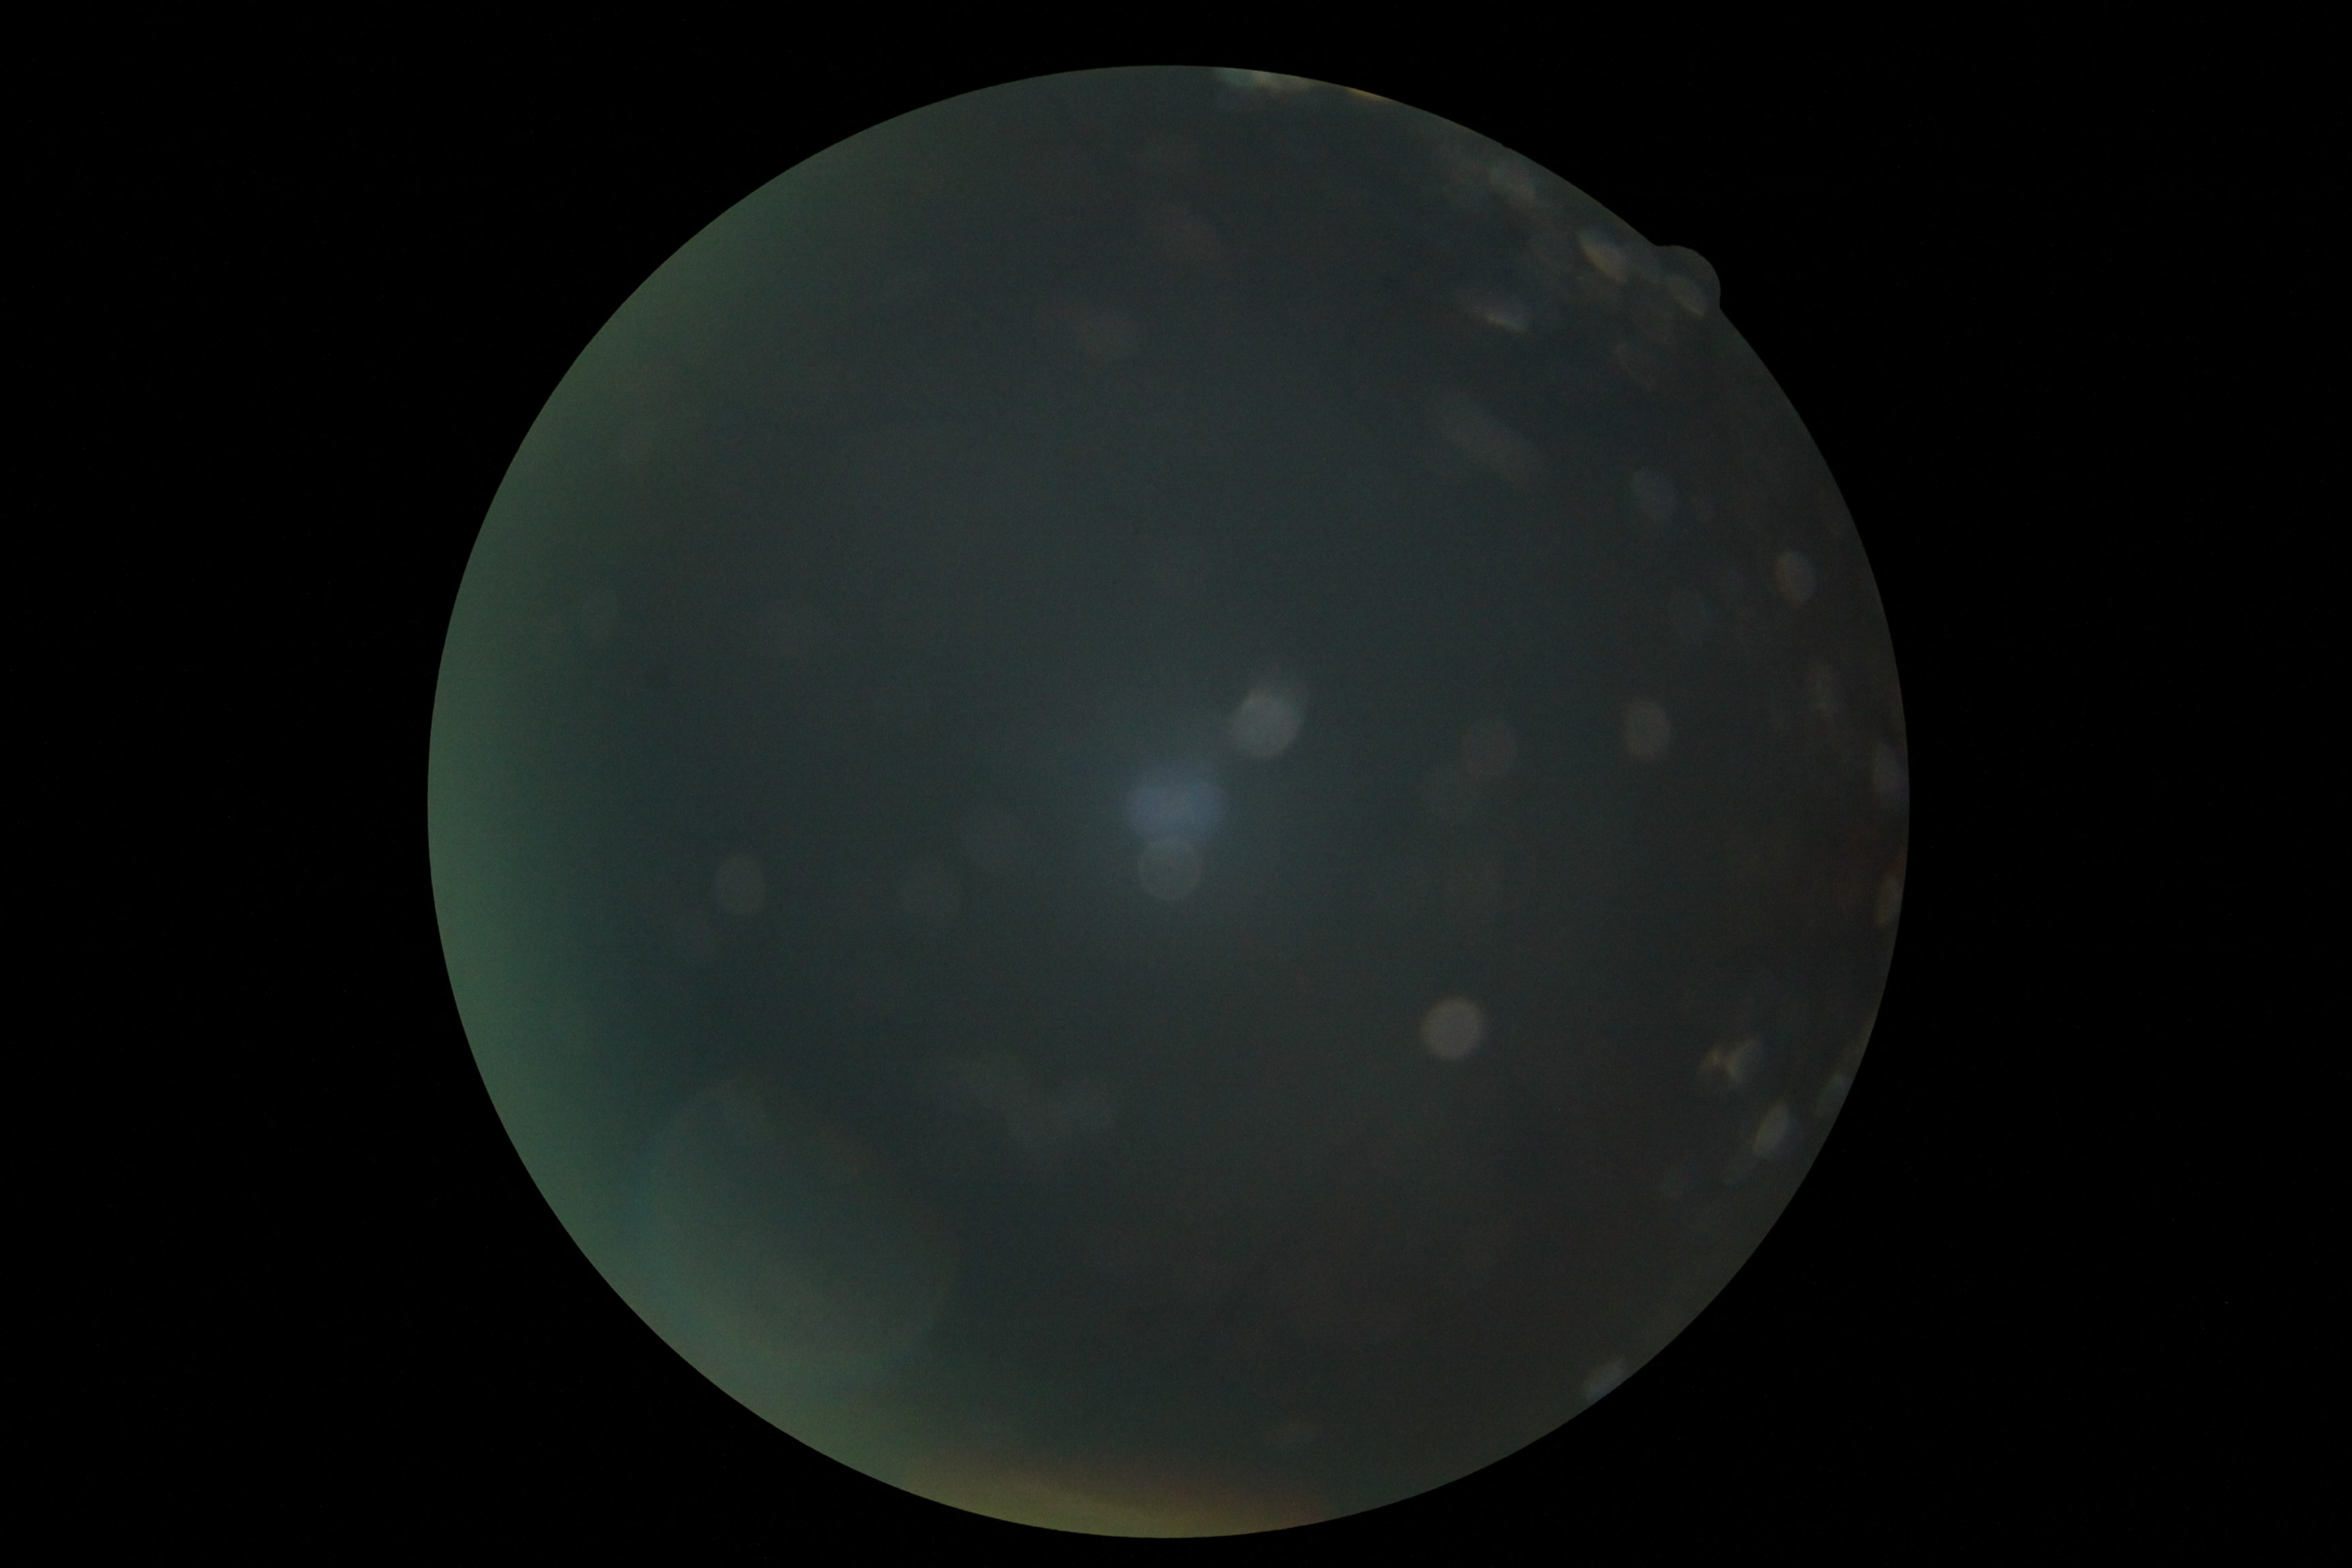

image quality = insufficient for DR assessment
diabetic retinopathy (DR) = ungradable due to poor image quality